FOV: 50 degrees. Tabletop color fundus camera image. 2361 x 1568 pixels: 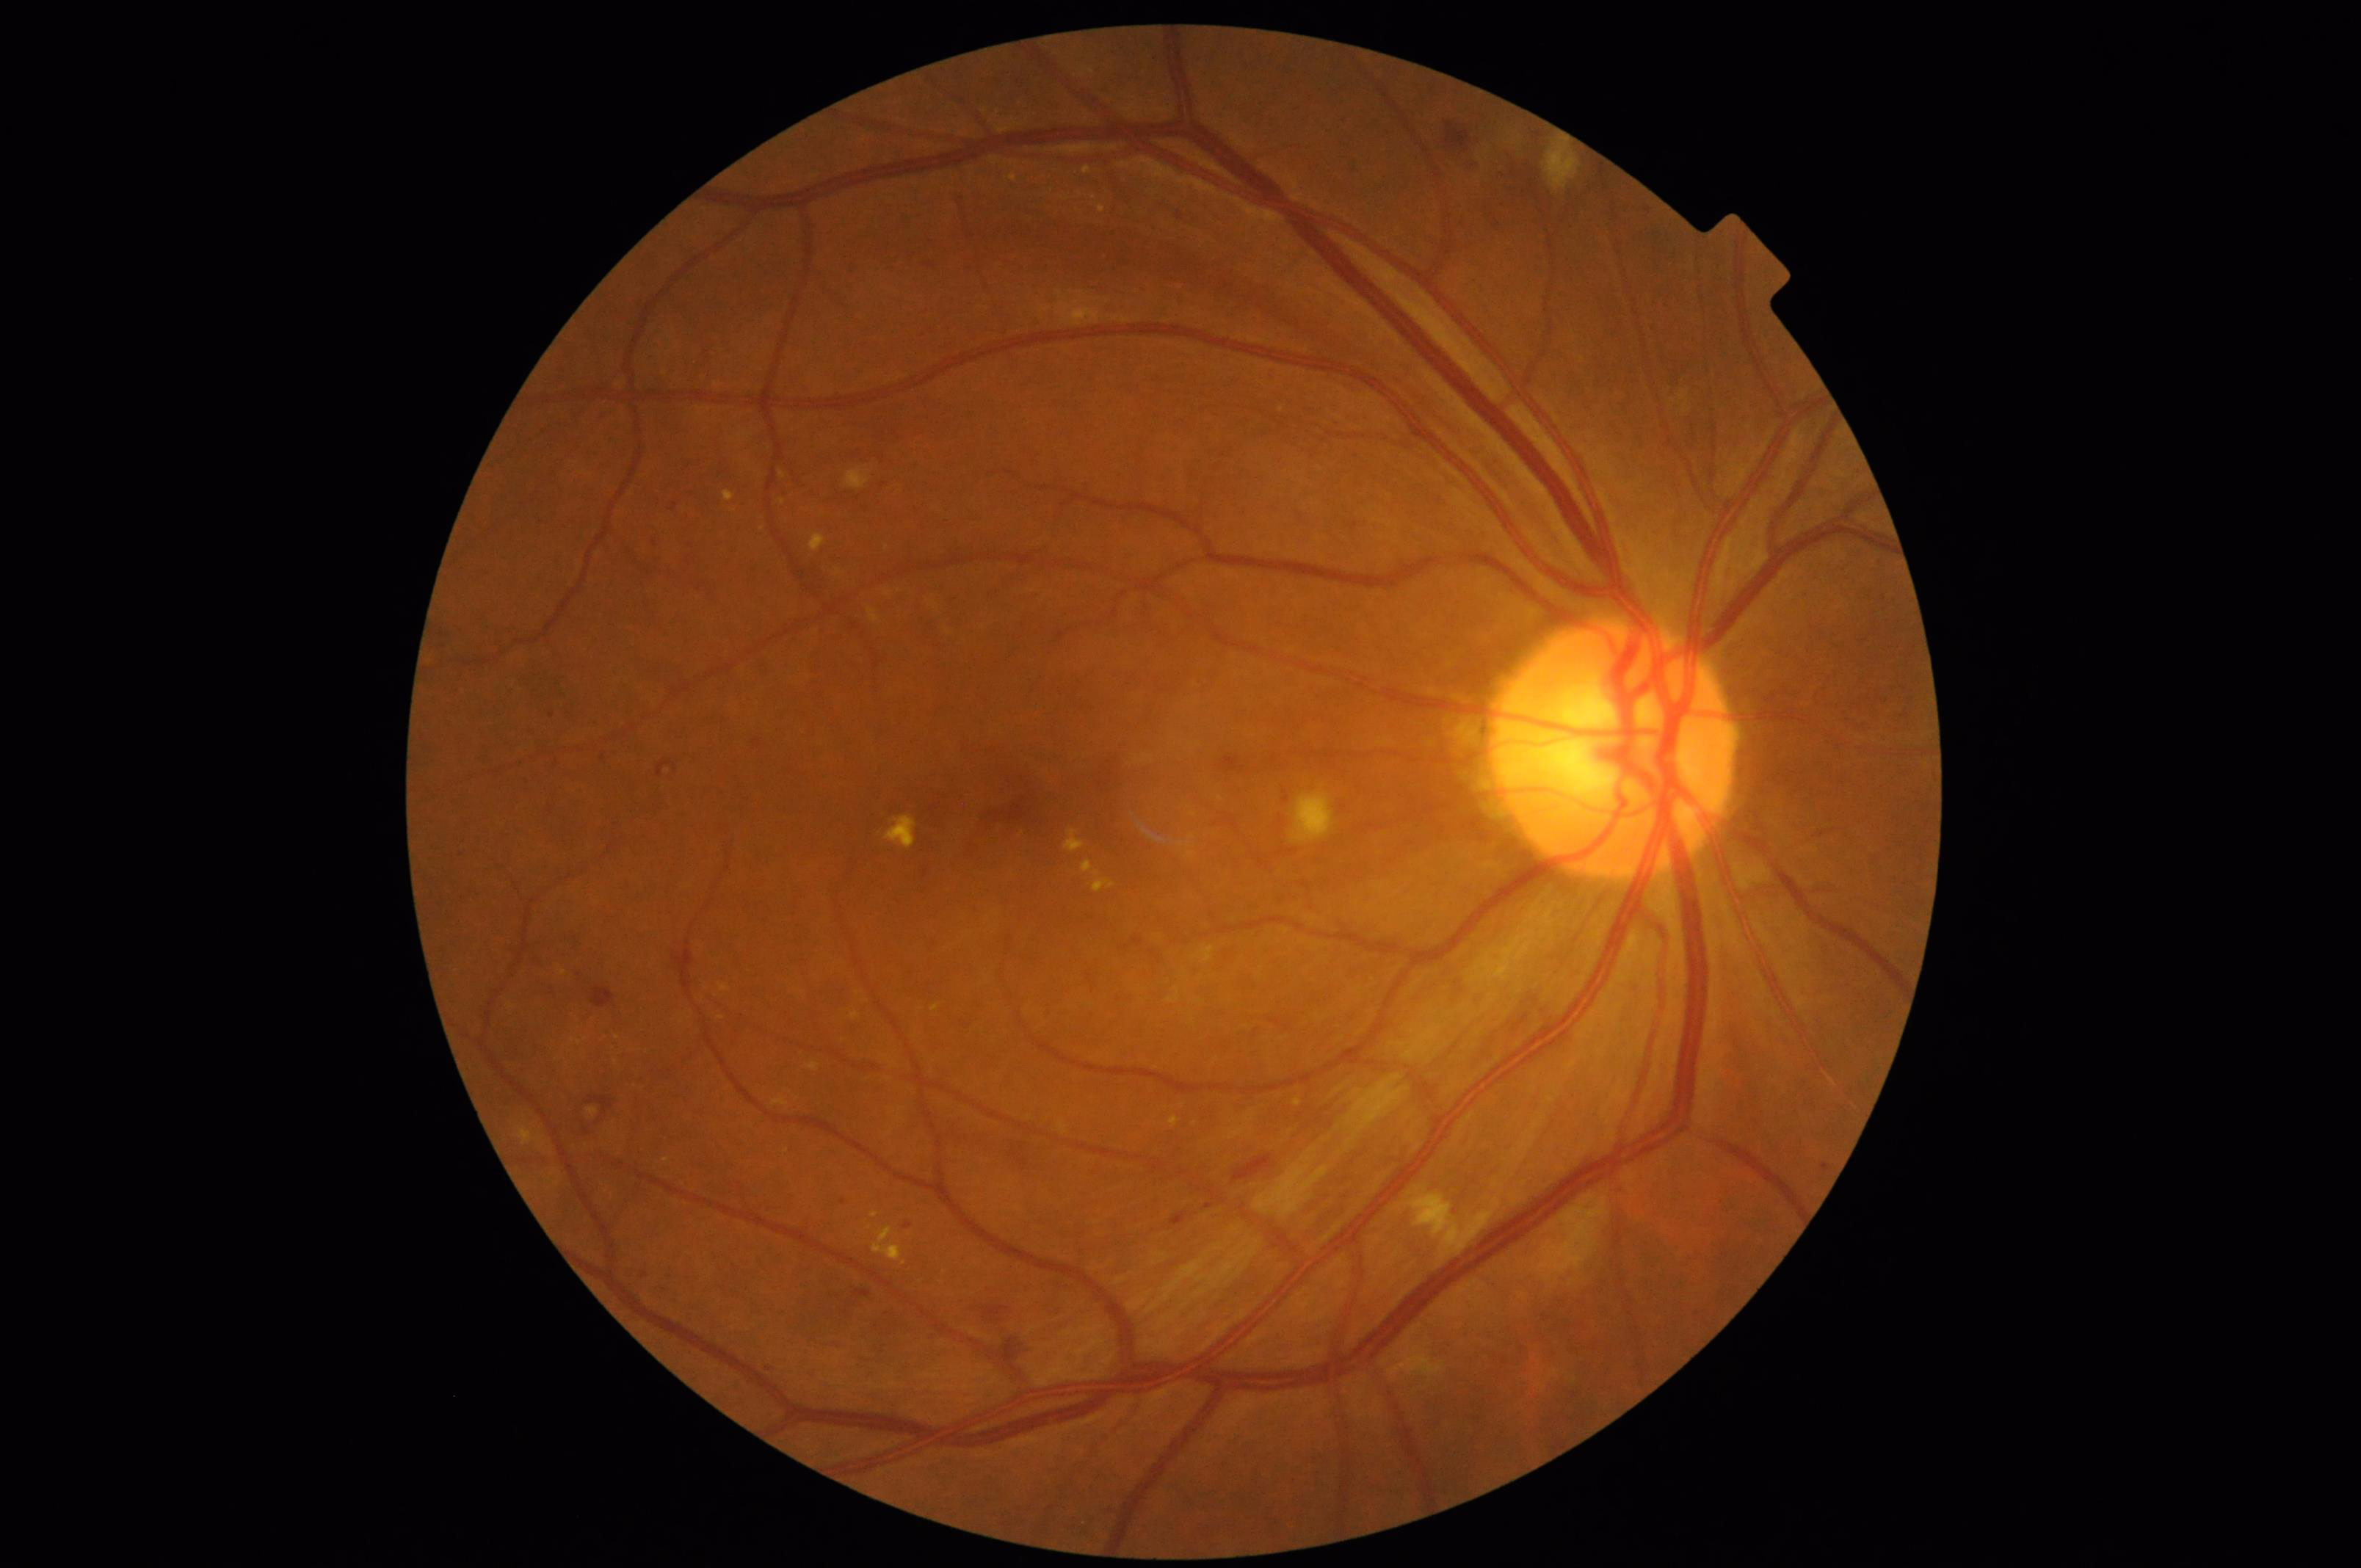 Contrast = good dynamic range; Clarity = sharp throughout the field; Overall image quality = good, gradable.